1932x1916px
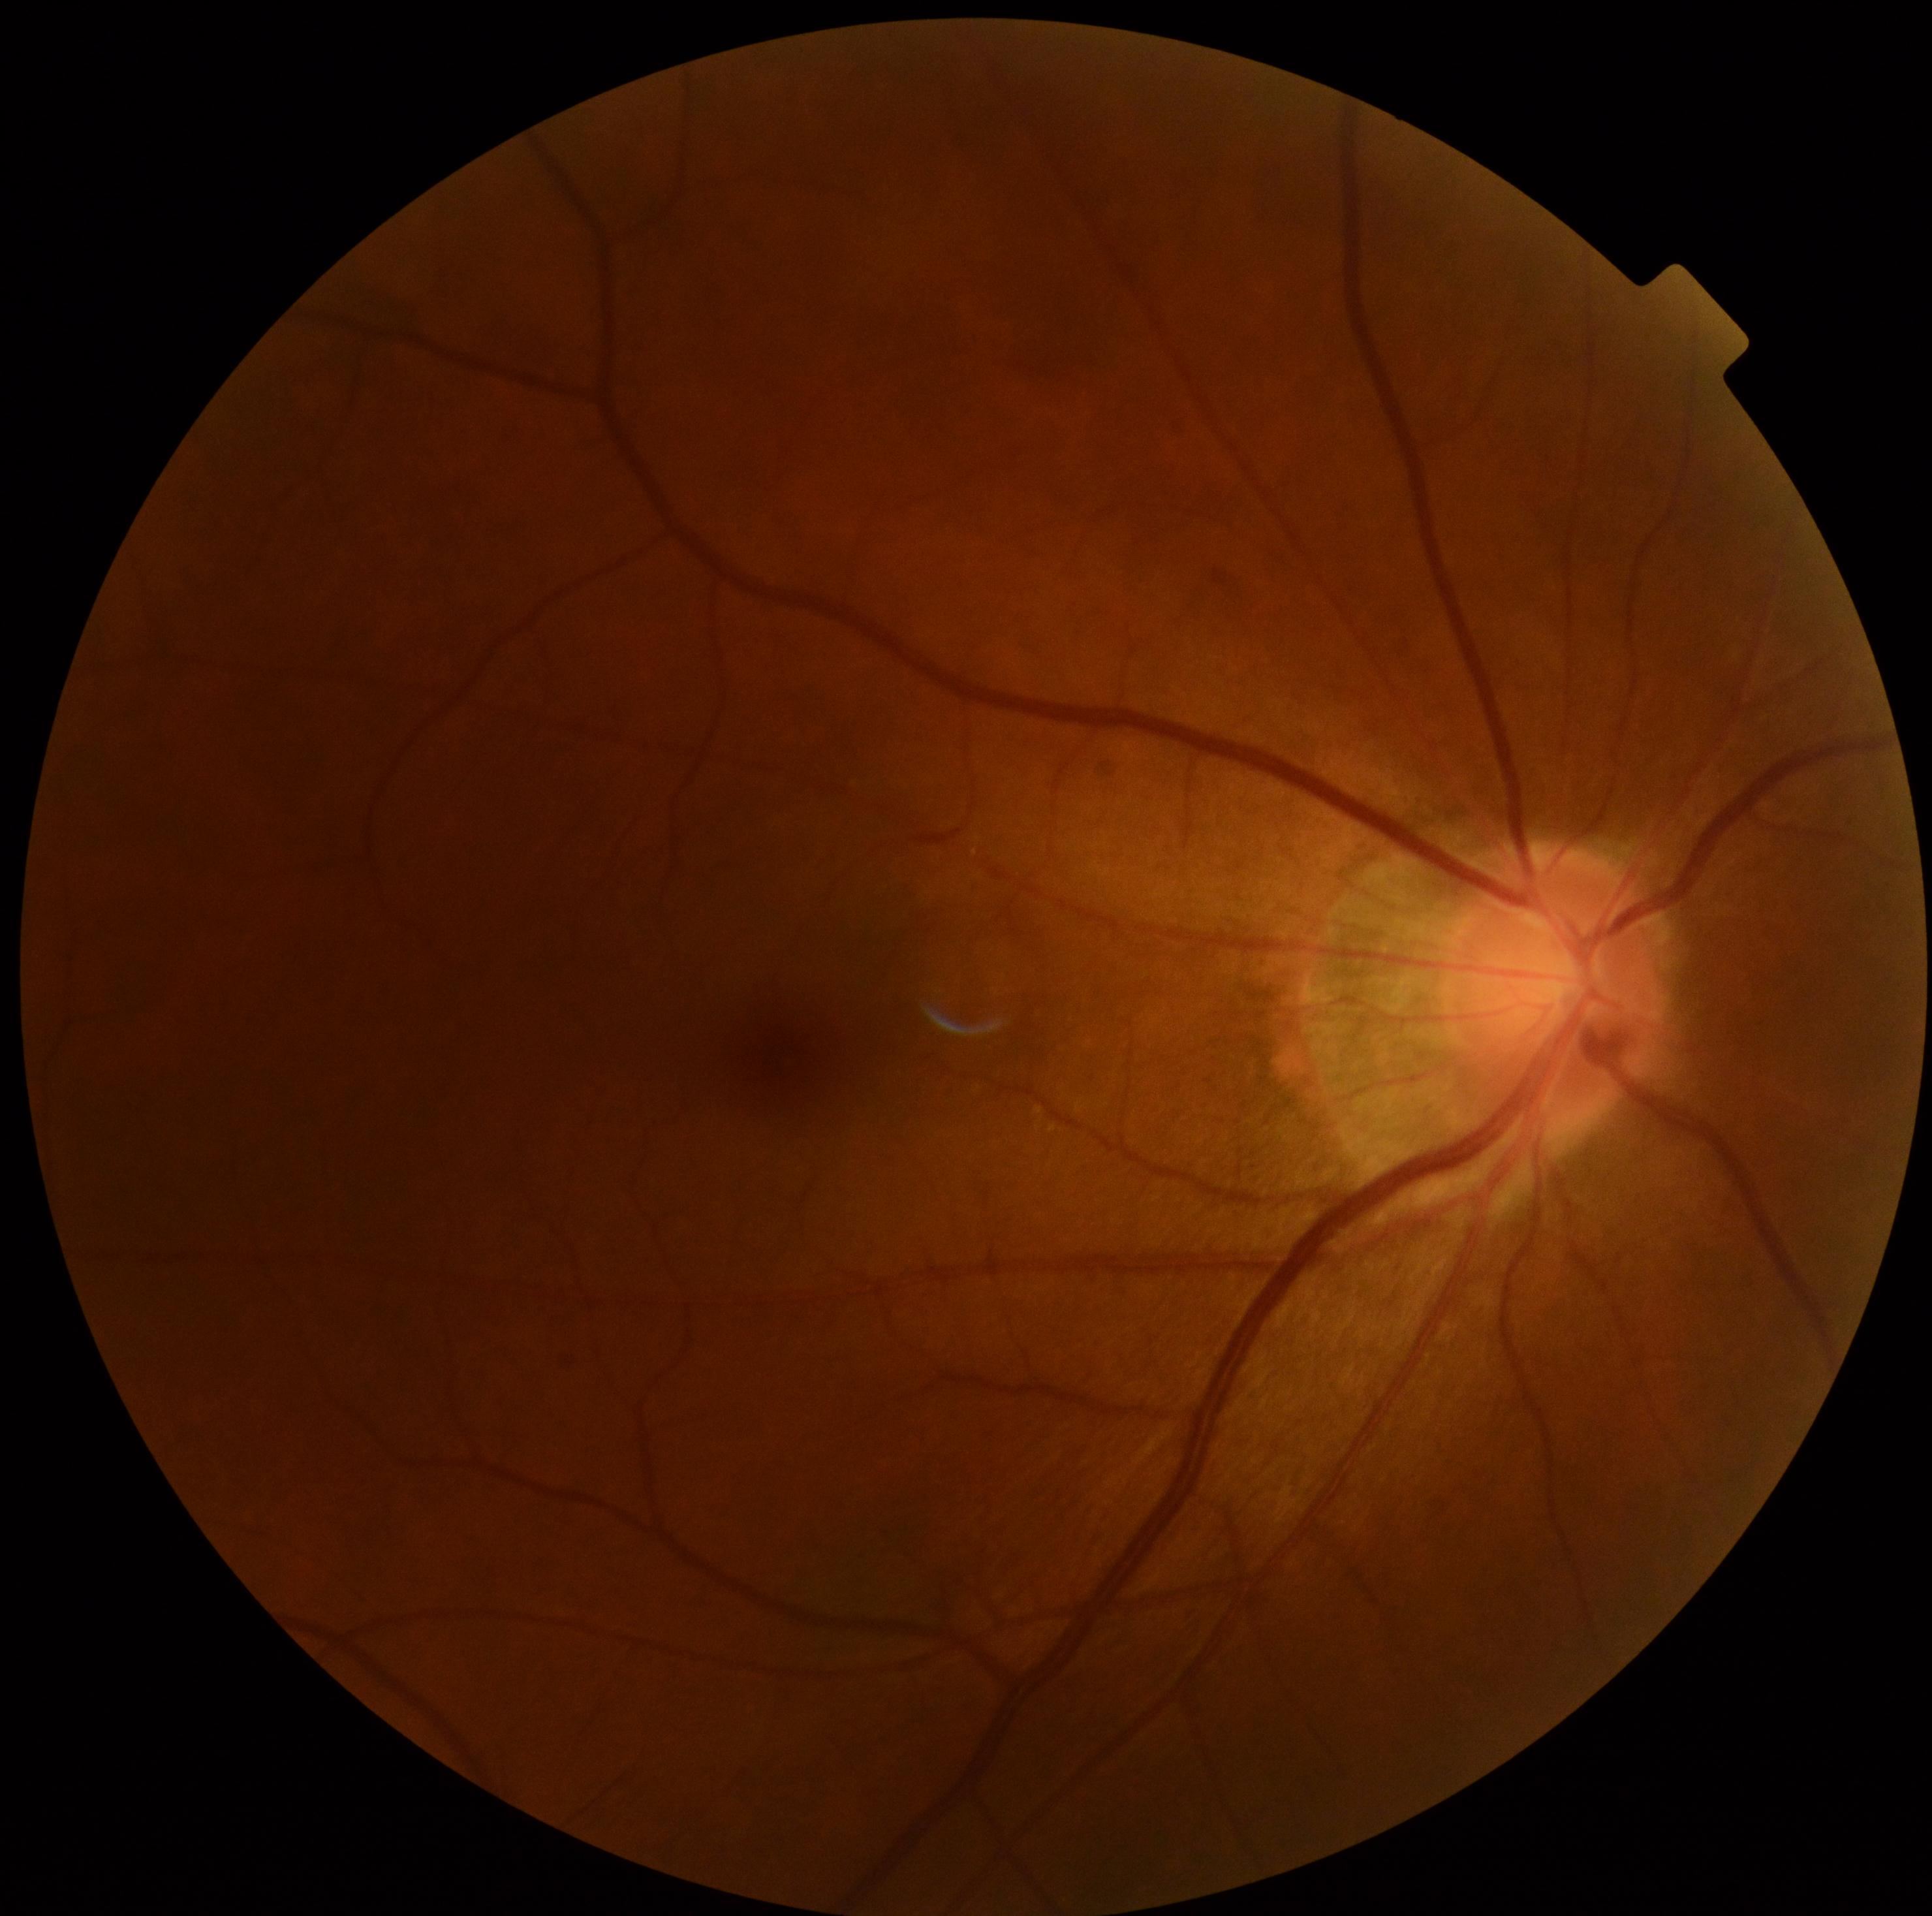
No apparent diabetic retinopathy.
Diabetic retinopathy (DR): grade 0.